Color fundus image. 2352x1568px
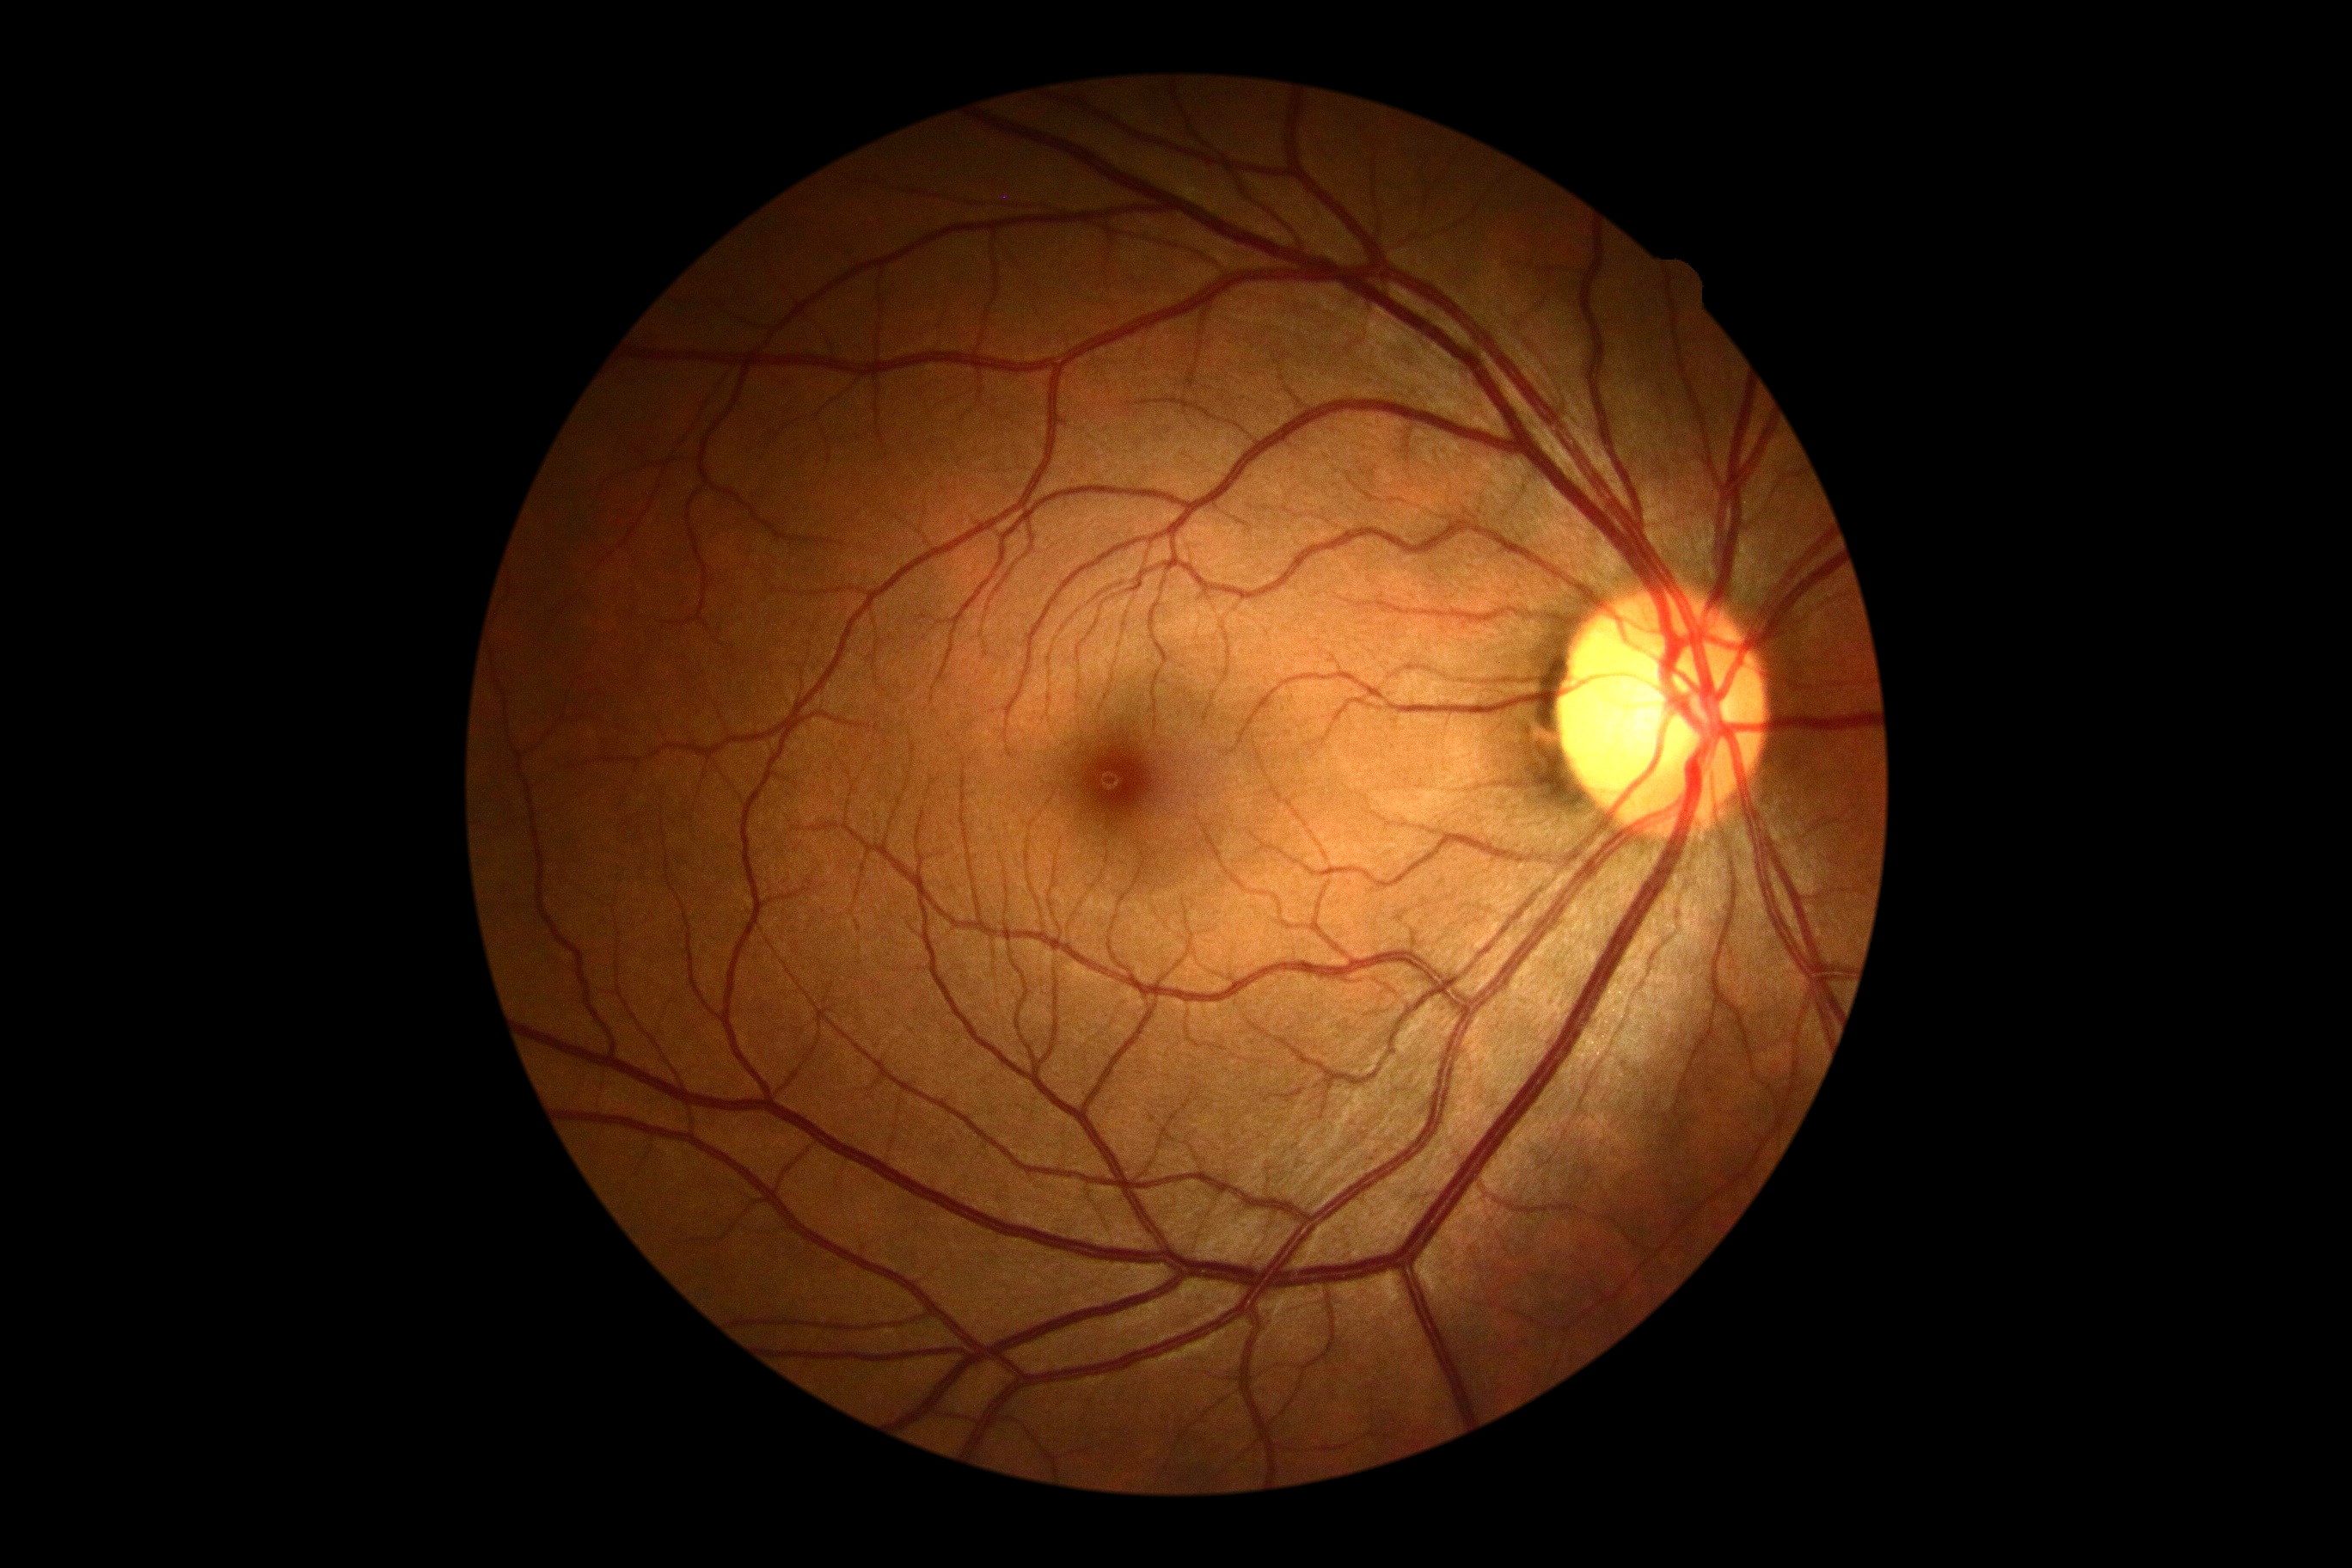

{"dr_grade": "0", "dr_impression": "no DR findings"}